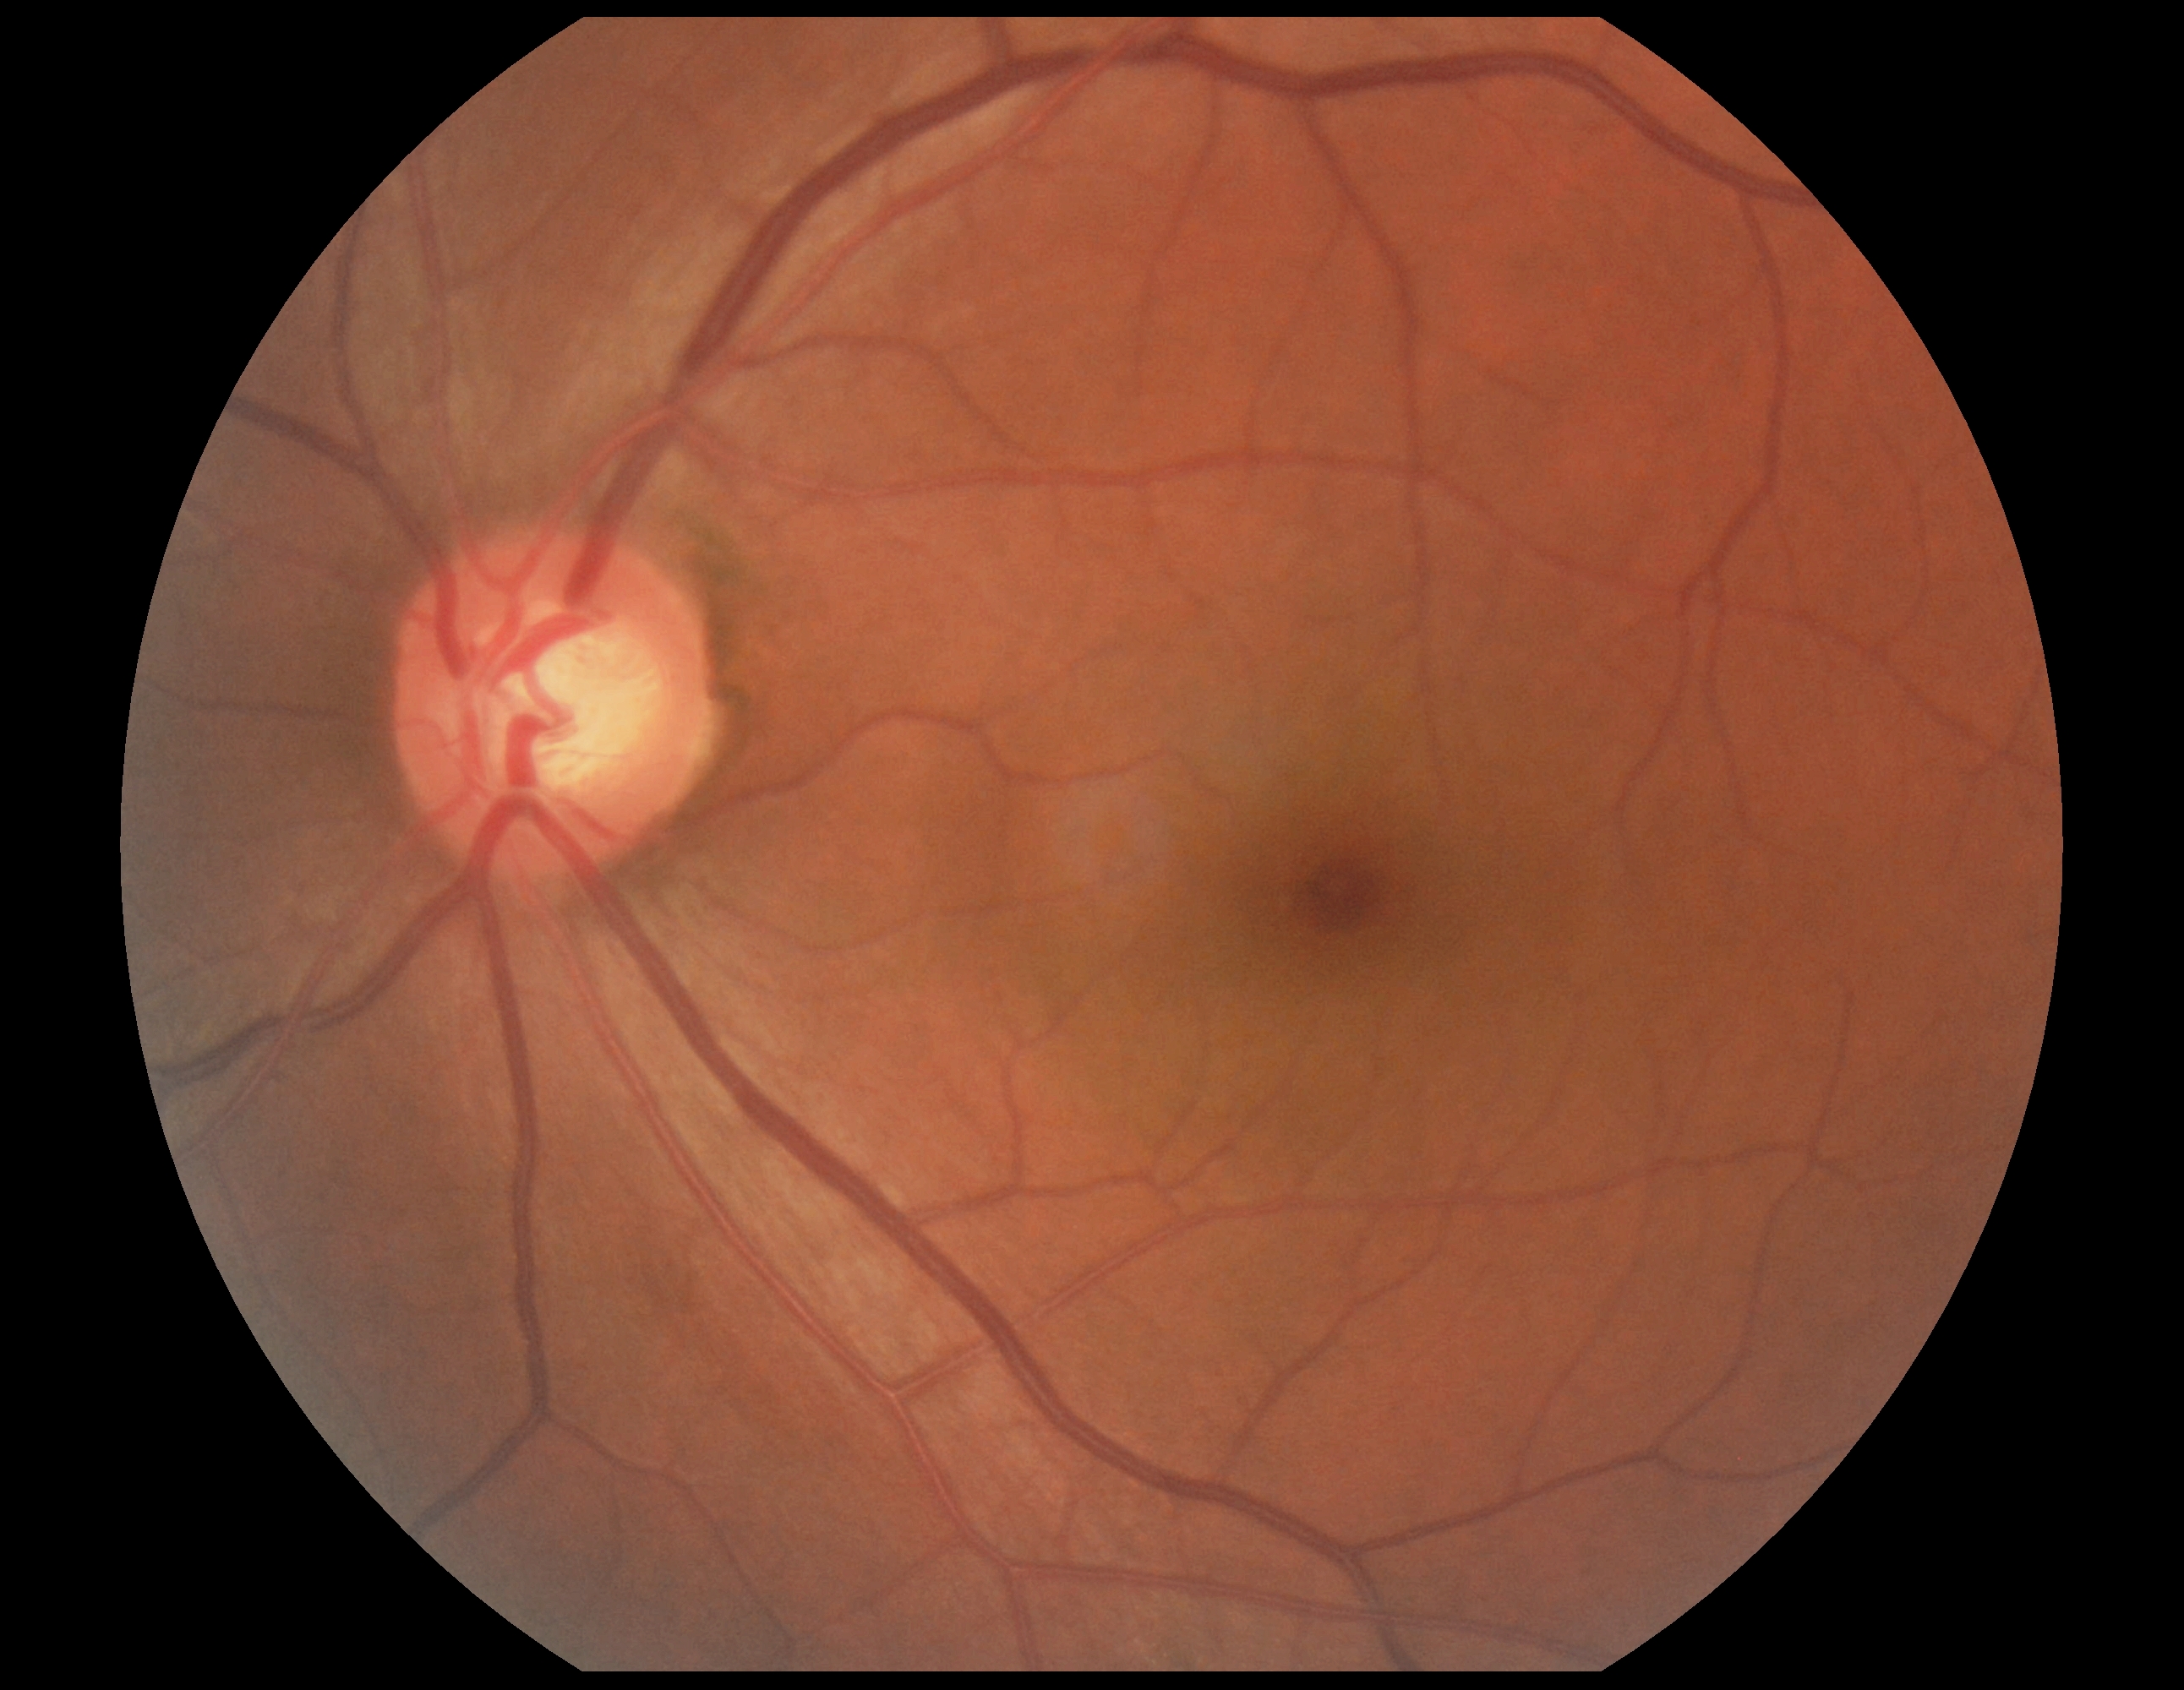
No DR findings. Retinopathy grade is 0 (no apparent retinopathy).